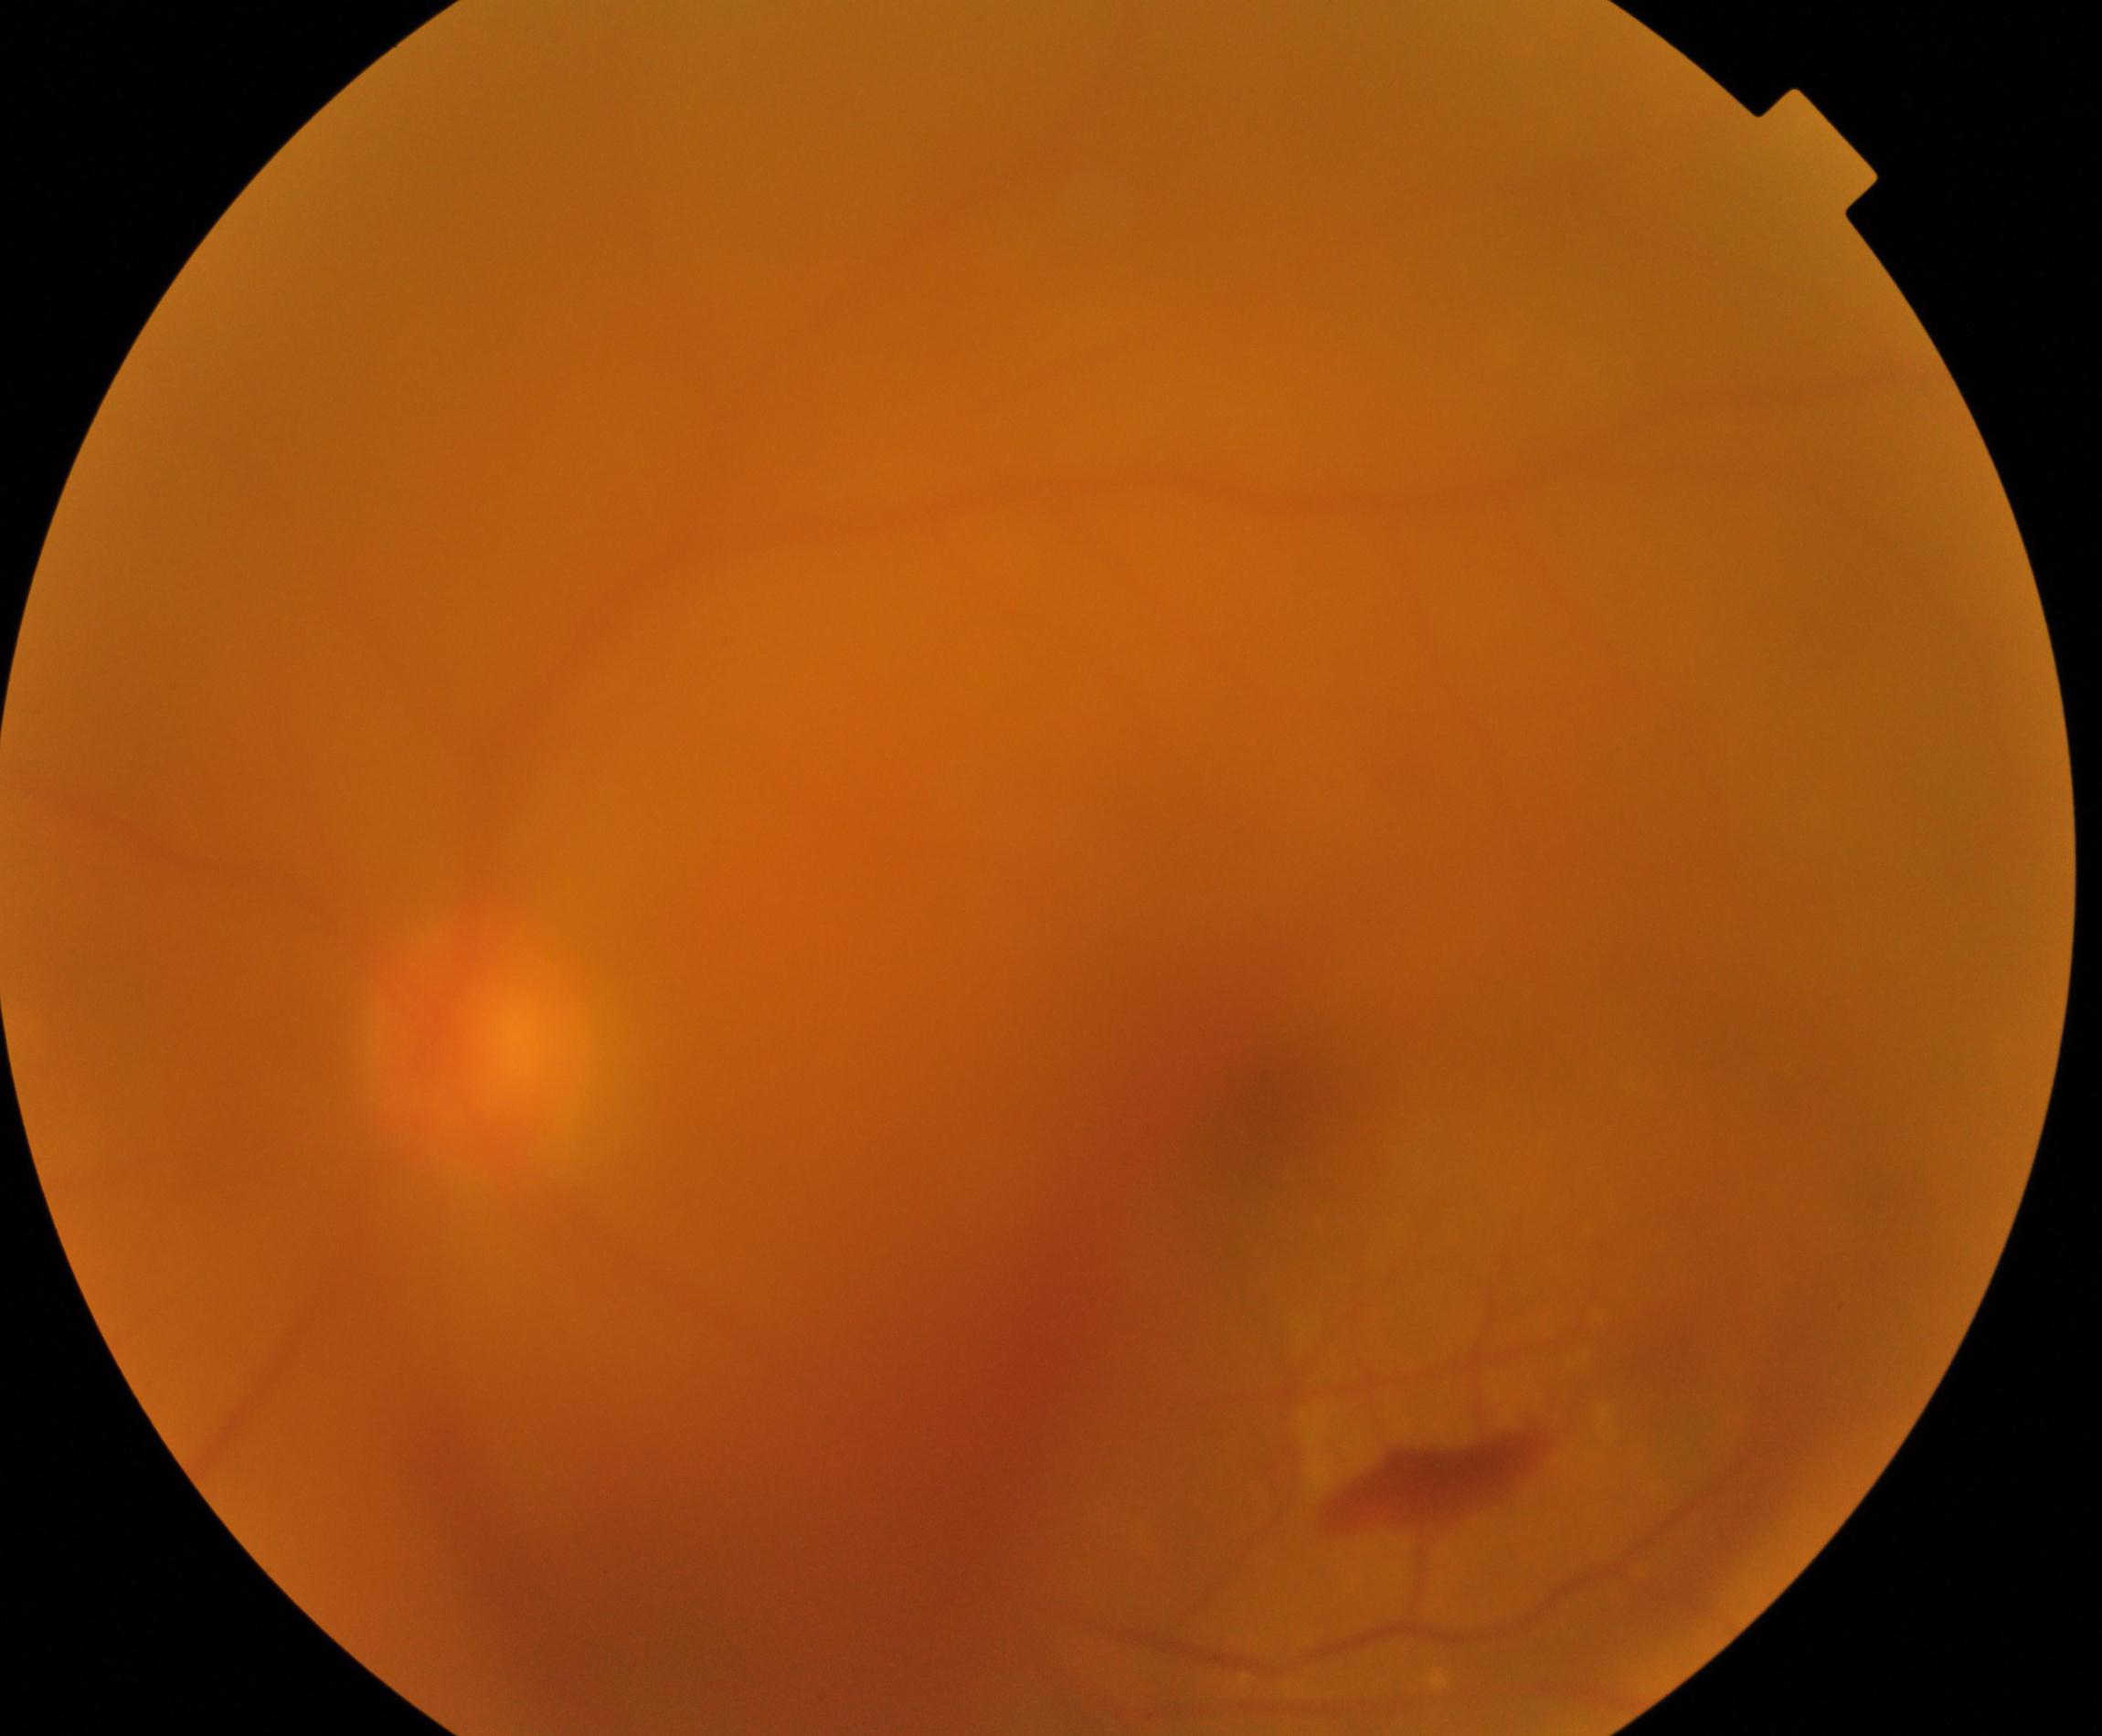
Image quality is poor; more than half the field is obscured. Suspected proliferative diabetic retinopathy.